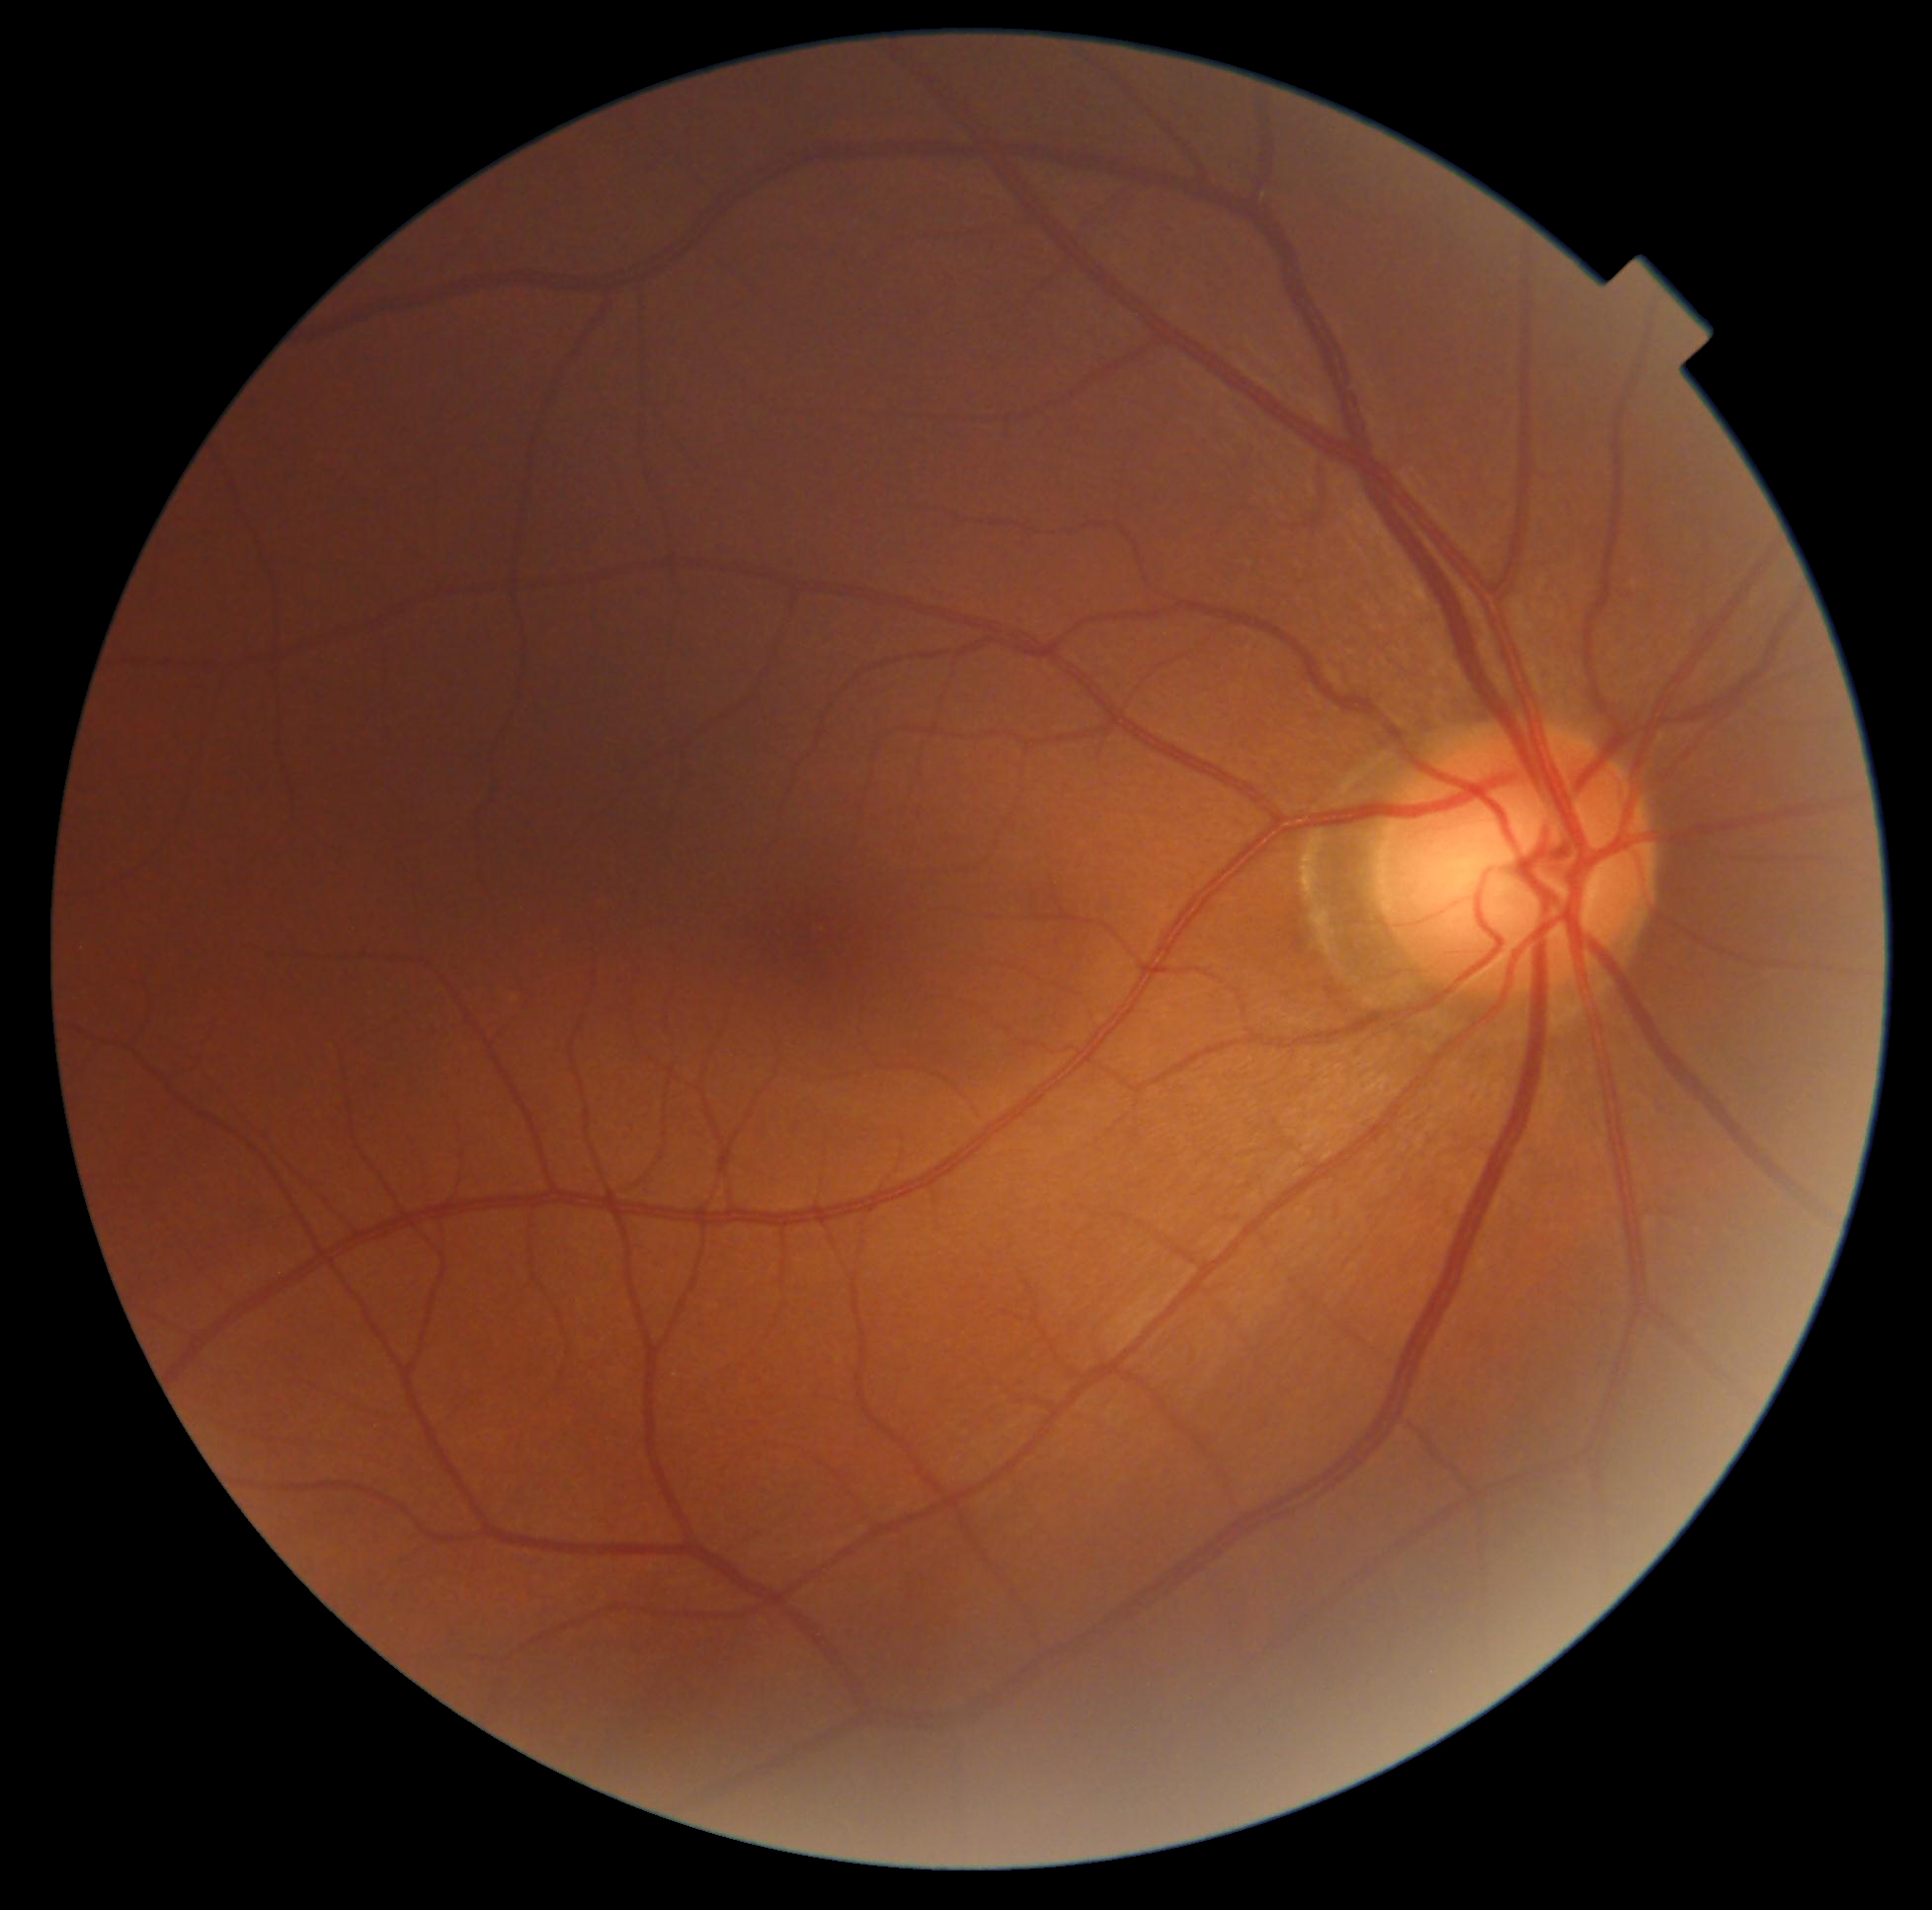

Diabetic retinopathy (DR): grade 0 (no apparent retinopathy).